Image size 1932x1910 · 45° field of view.
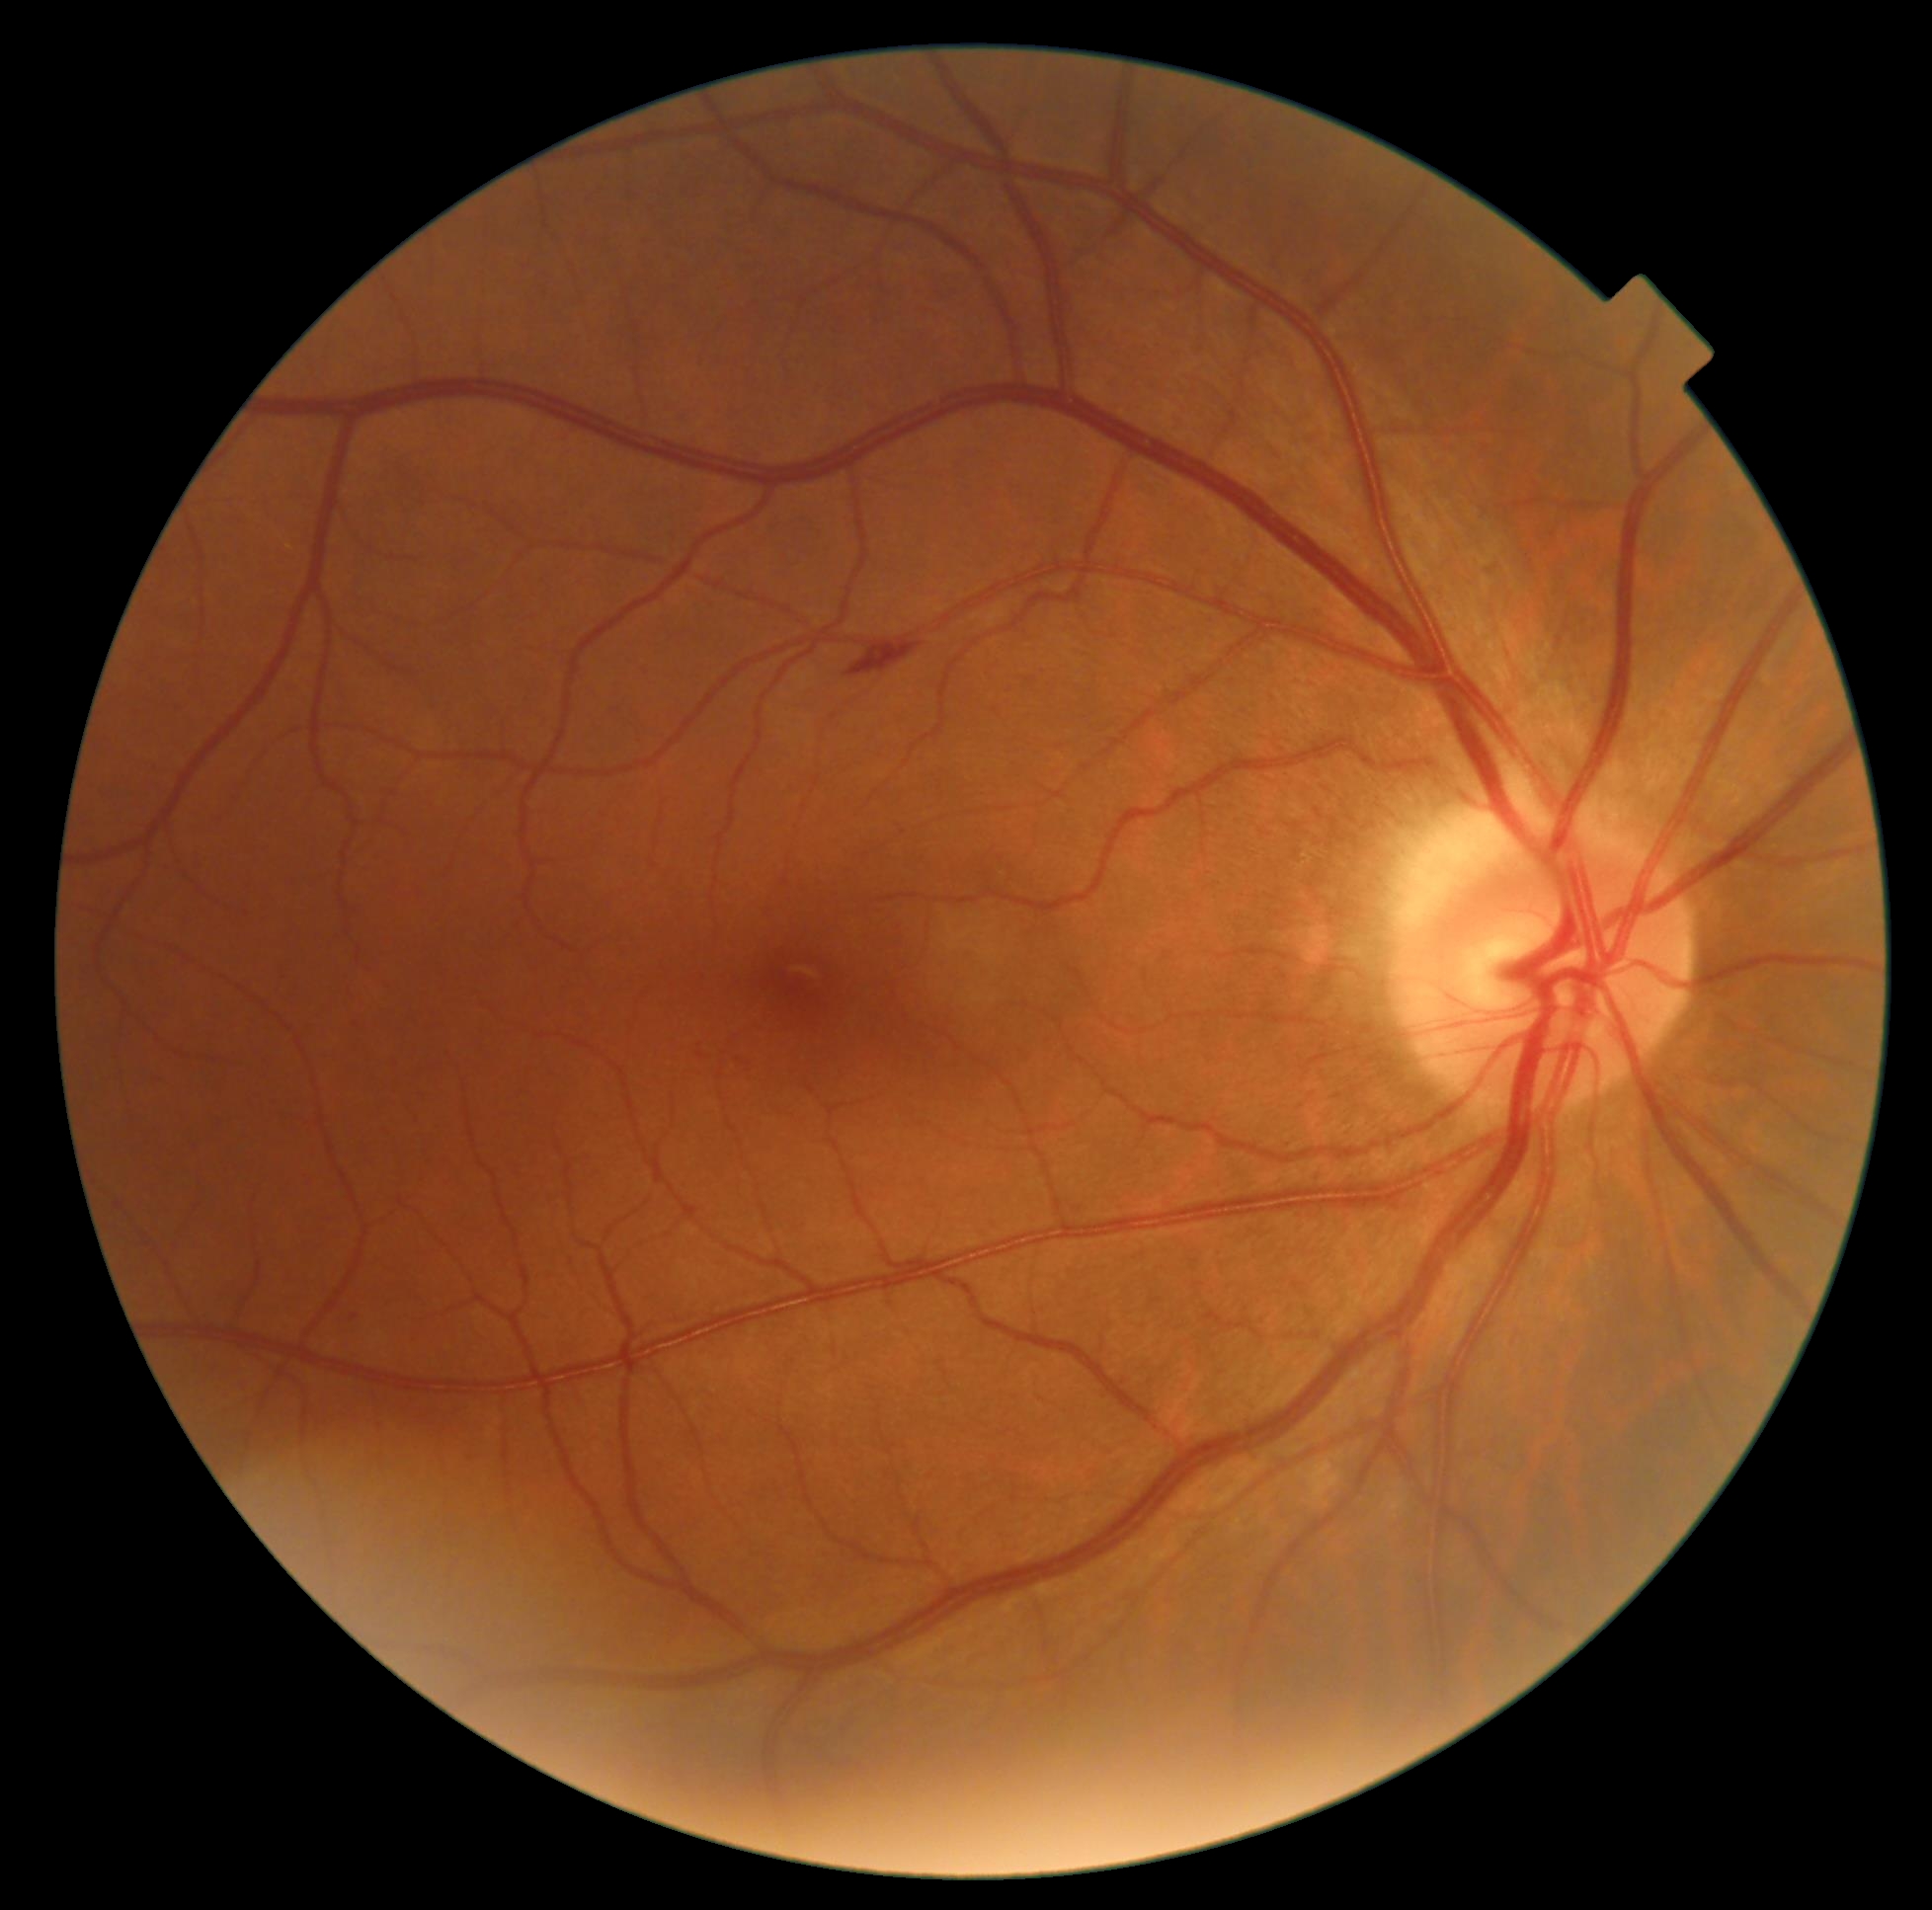

retinopathy = grade 2.